Wide-field fundus image from infant ROP screening · 100° field of view (Phoenix ICON): 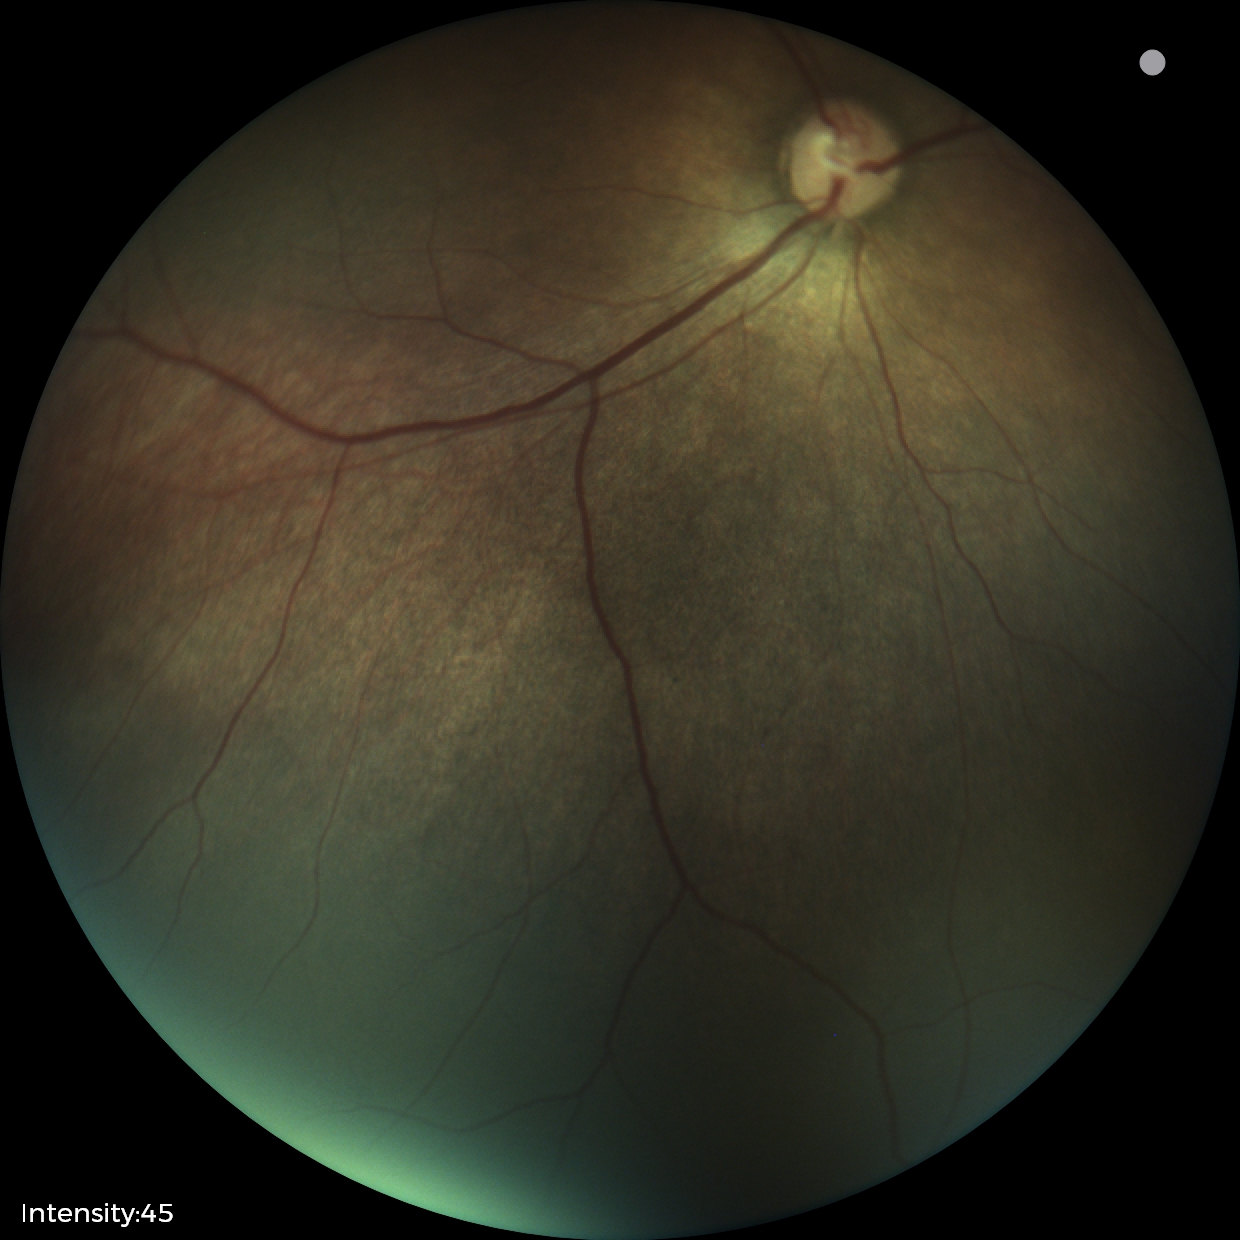
Q: What is the diagnosis from this examination?
A: status post ROP — retinal appearance after treated retinopathy of prematurity